Tabletop color fundus camera image, 1534x1534px, FOV: 50 degrees — 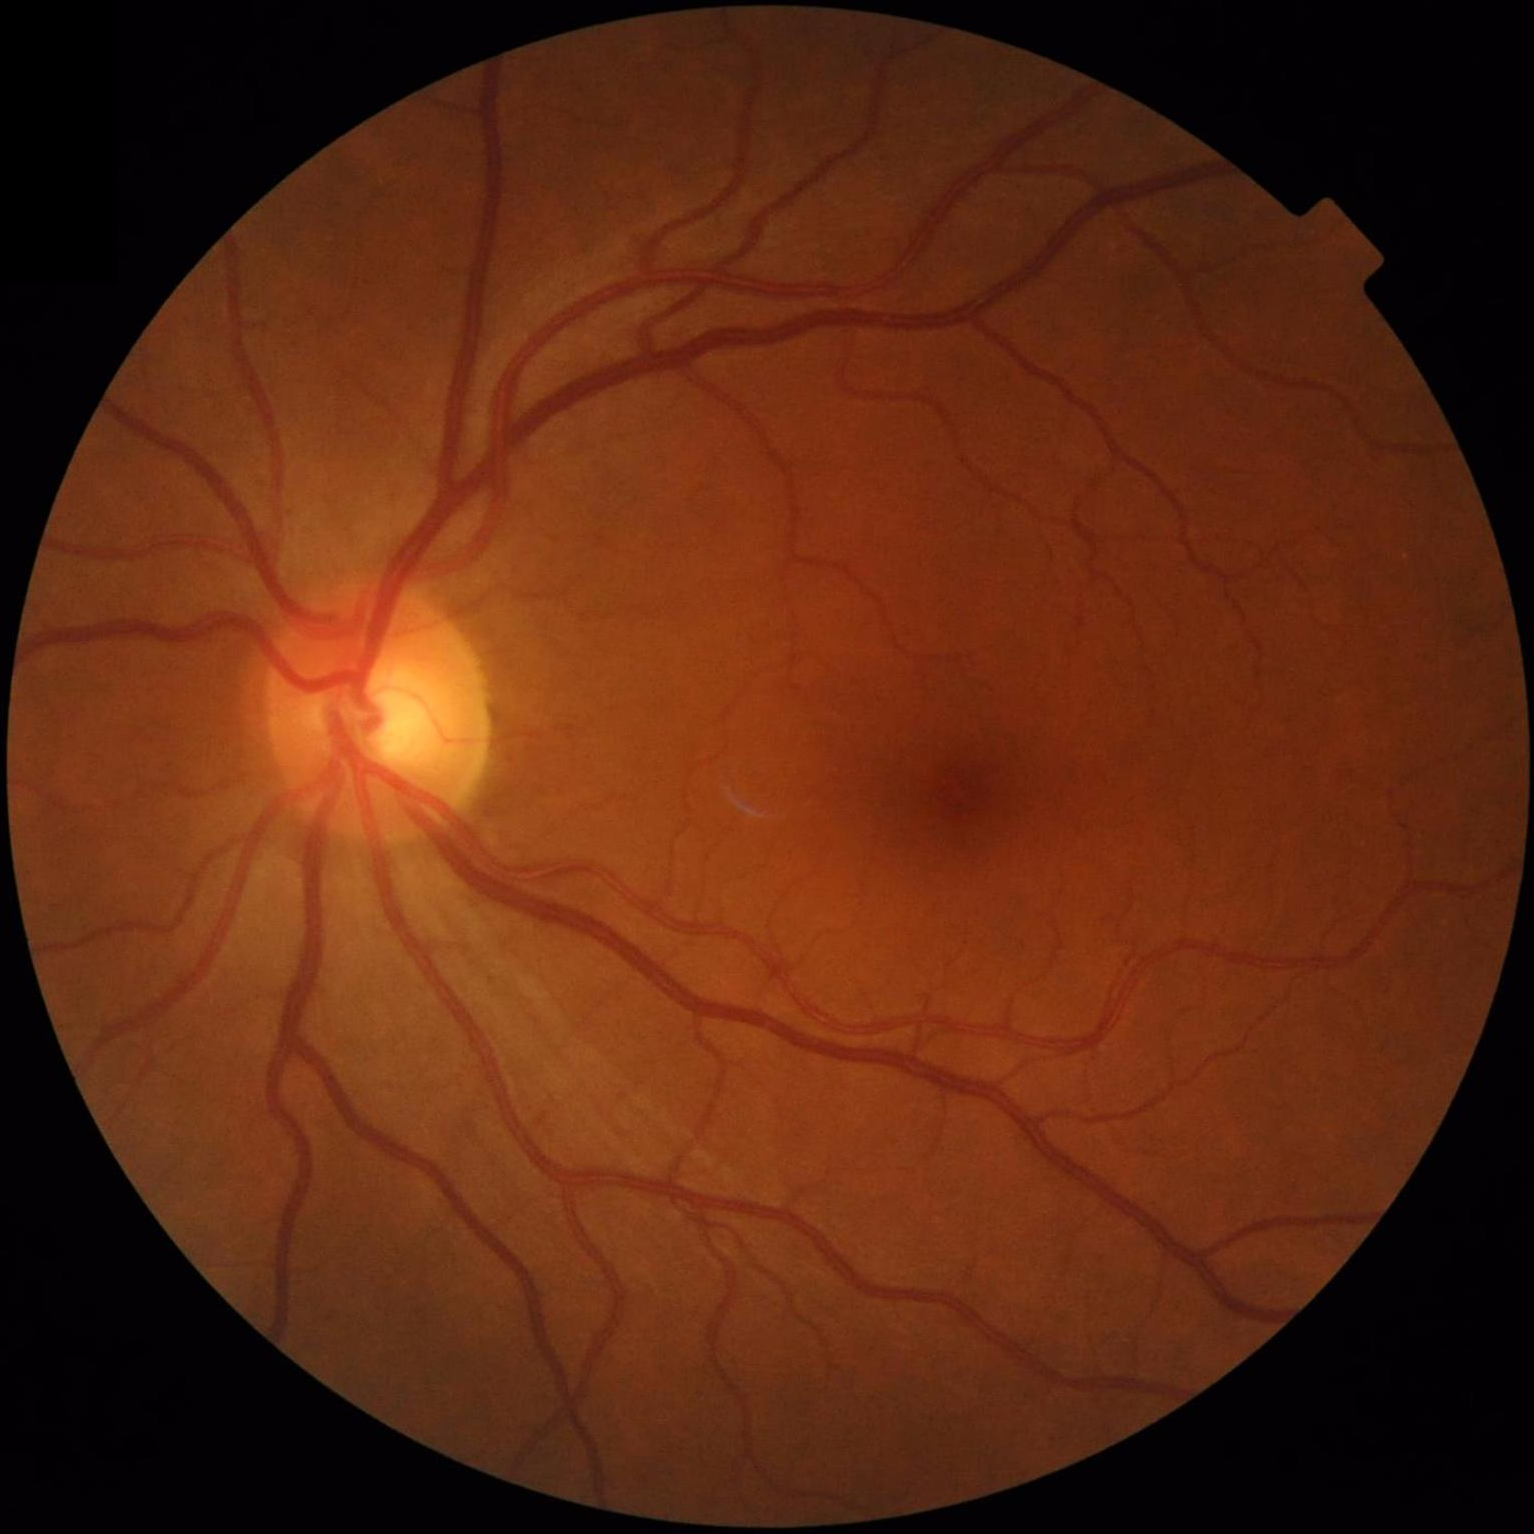 Sharpness: in focus; Illumination/color: good; Overall quality: acceptable.